45-degree field of view · modified Davis classification · CFP · nonmydriatic.
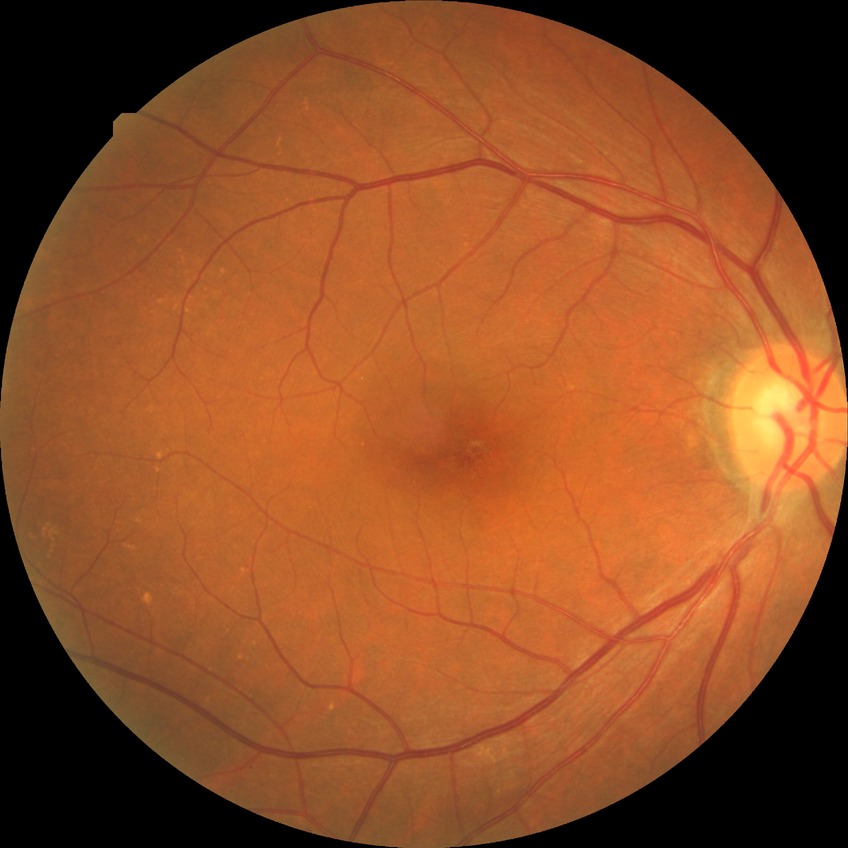
{"davis_grade": "NDR (no diabetic retinopathy)"}